848 by 848 pixels, 45 degree fundus photograph, NIDEK AFC-230, without pupil dilation, CFP.
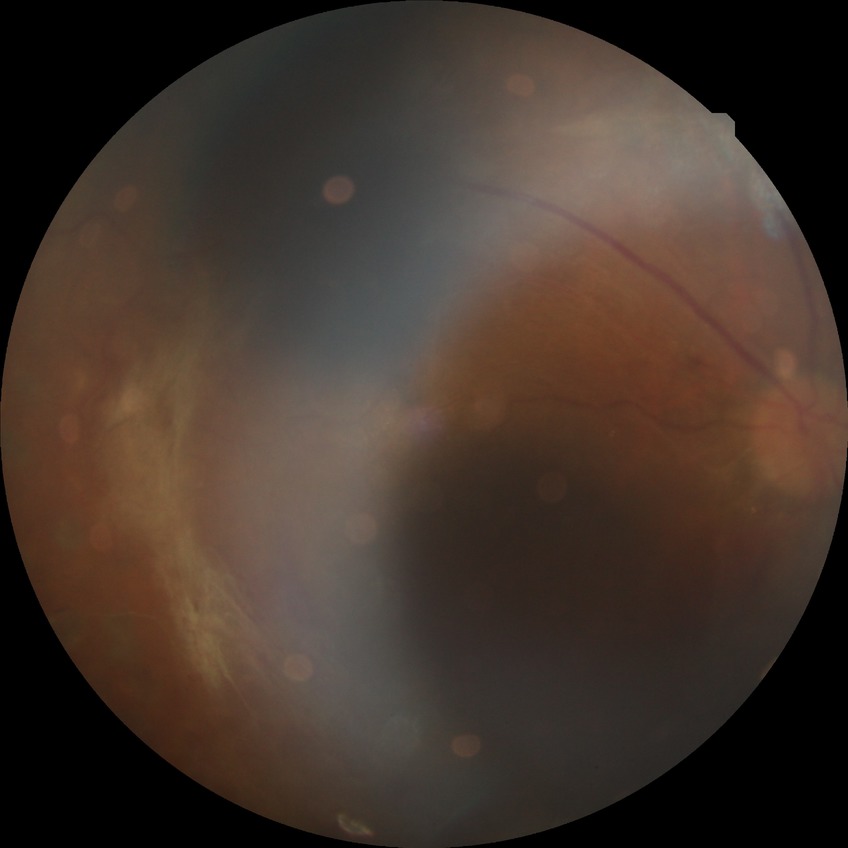   davis_grade: proliferative diabetic retinopathy